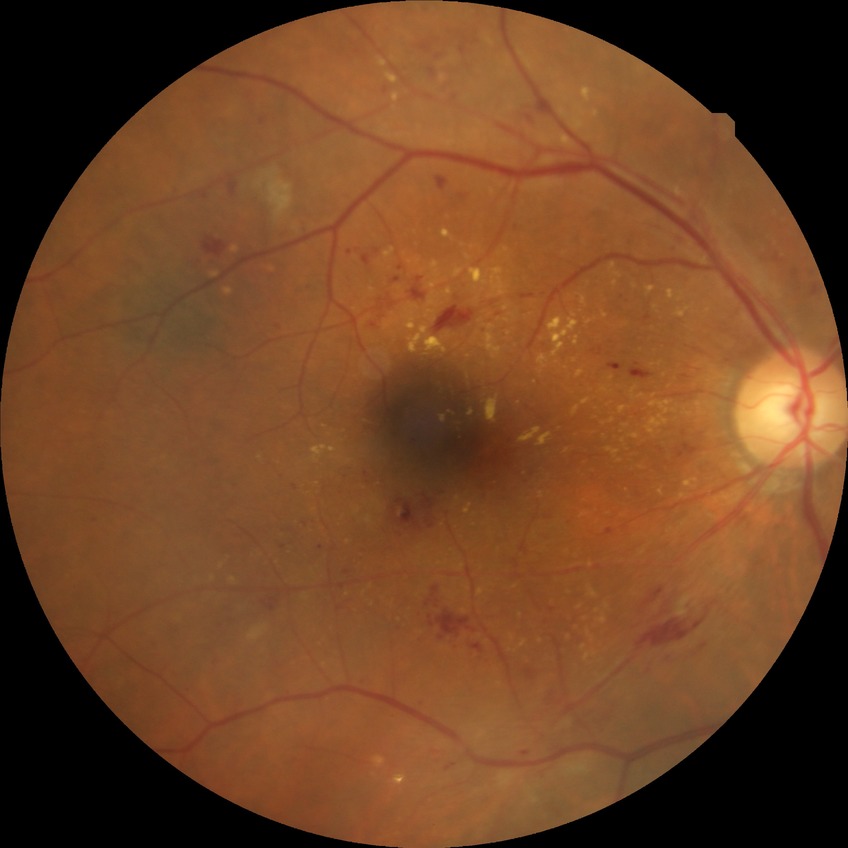

Diabetic retinopathy (DR) is pre-proliferative diabetic retinopathy (PPDR).